Image size 848x848, acquired with a NIDEK AFC-230:
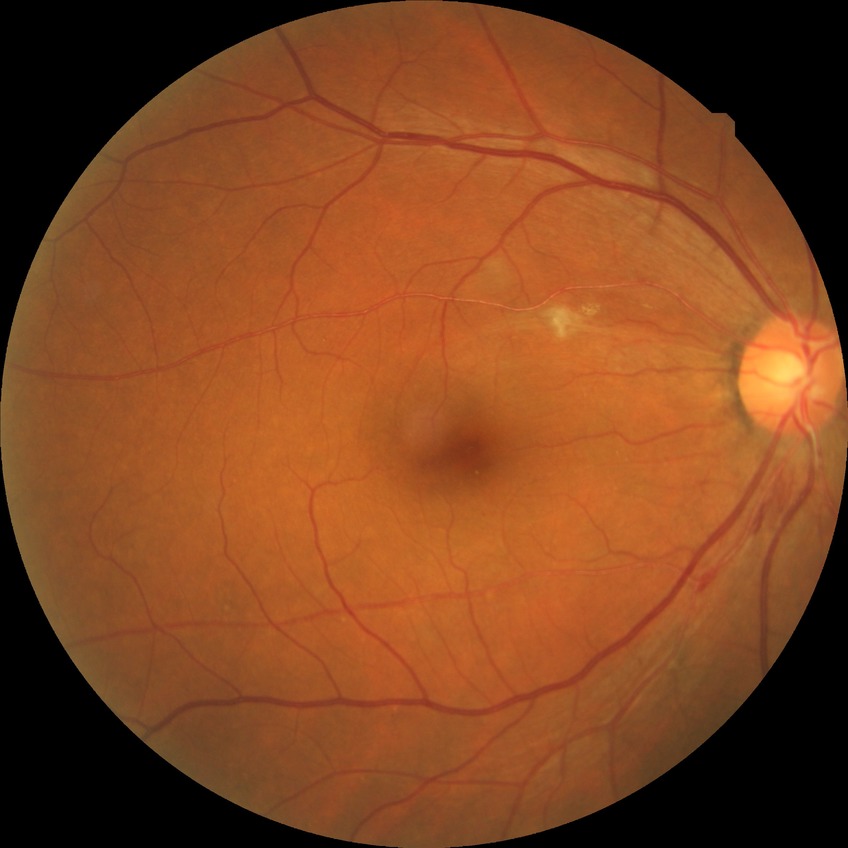

DR: NDR.